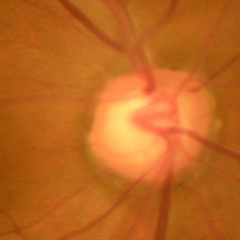
Optic disc photograph demonstrating early-stage glaucoma.